1240 x 1240 pixels · pediatric retinal photograph (wide-field) · 100° field of view (Phoenix ICON)
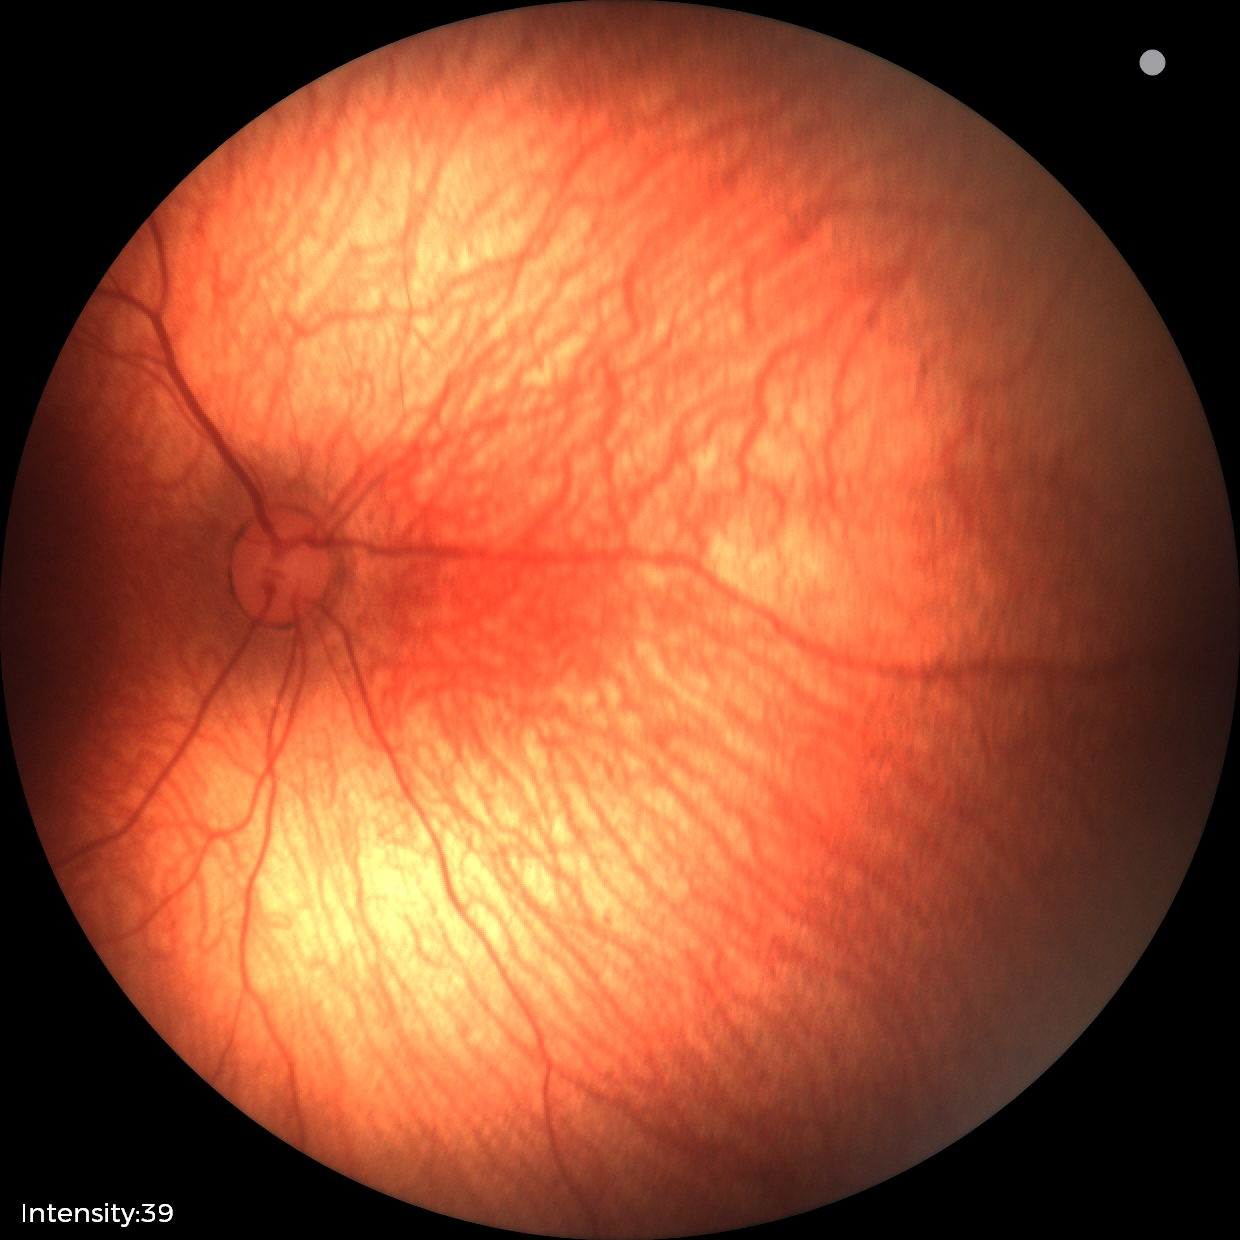 Diagnosis: normal retinal appearance.